Wide-field contact fundus photograph of an infant · acquired on the Clarity RetCam 3.
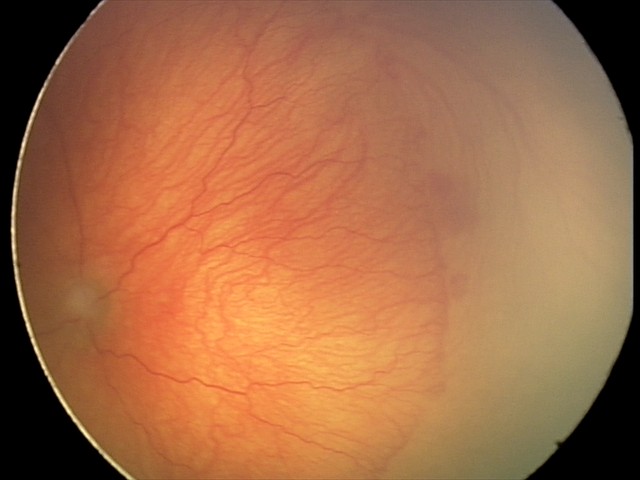
Assessment: plus disease — abnormal dilation and tortuosity of the posterior pole retinal vessels; aggressive retinopathy of prematurity (A-ROP).